Color fundus image — 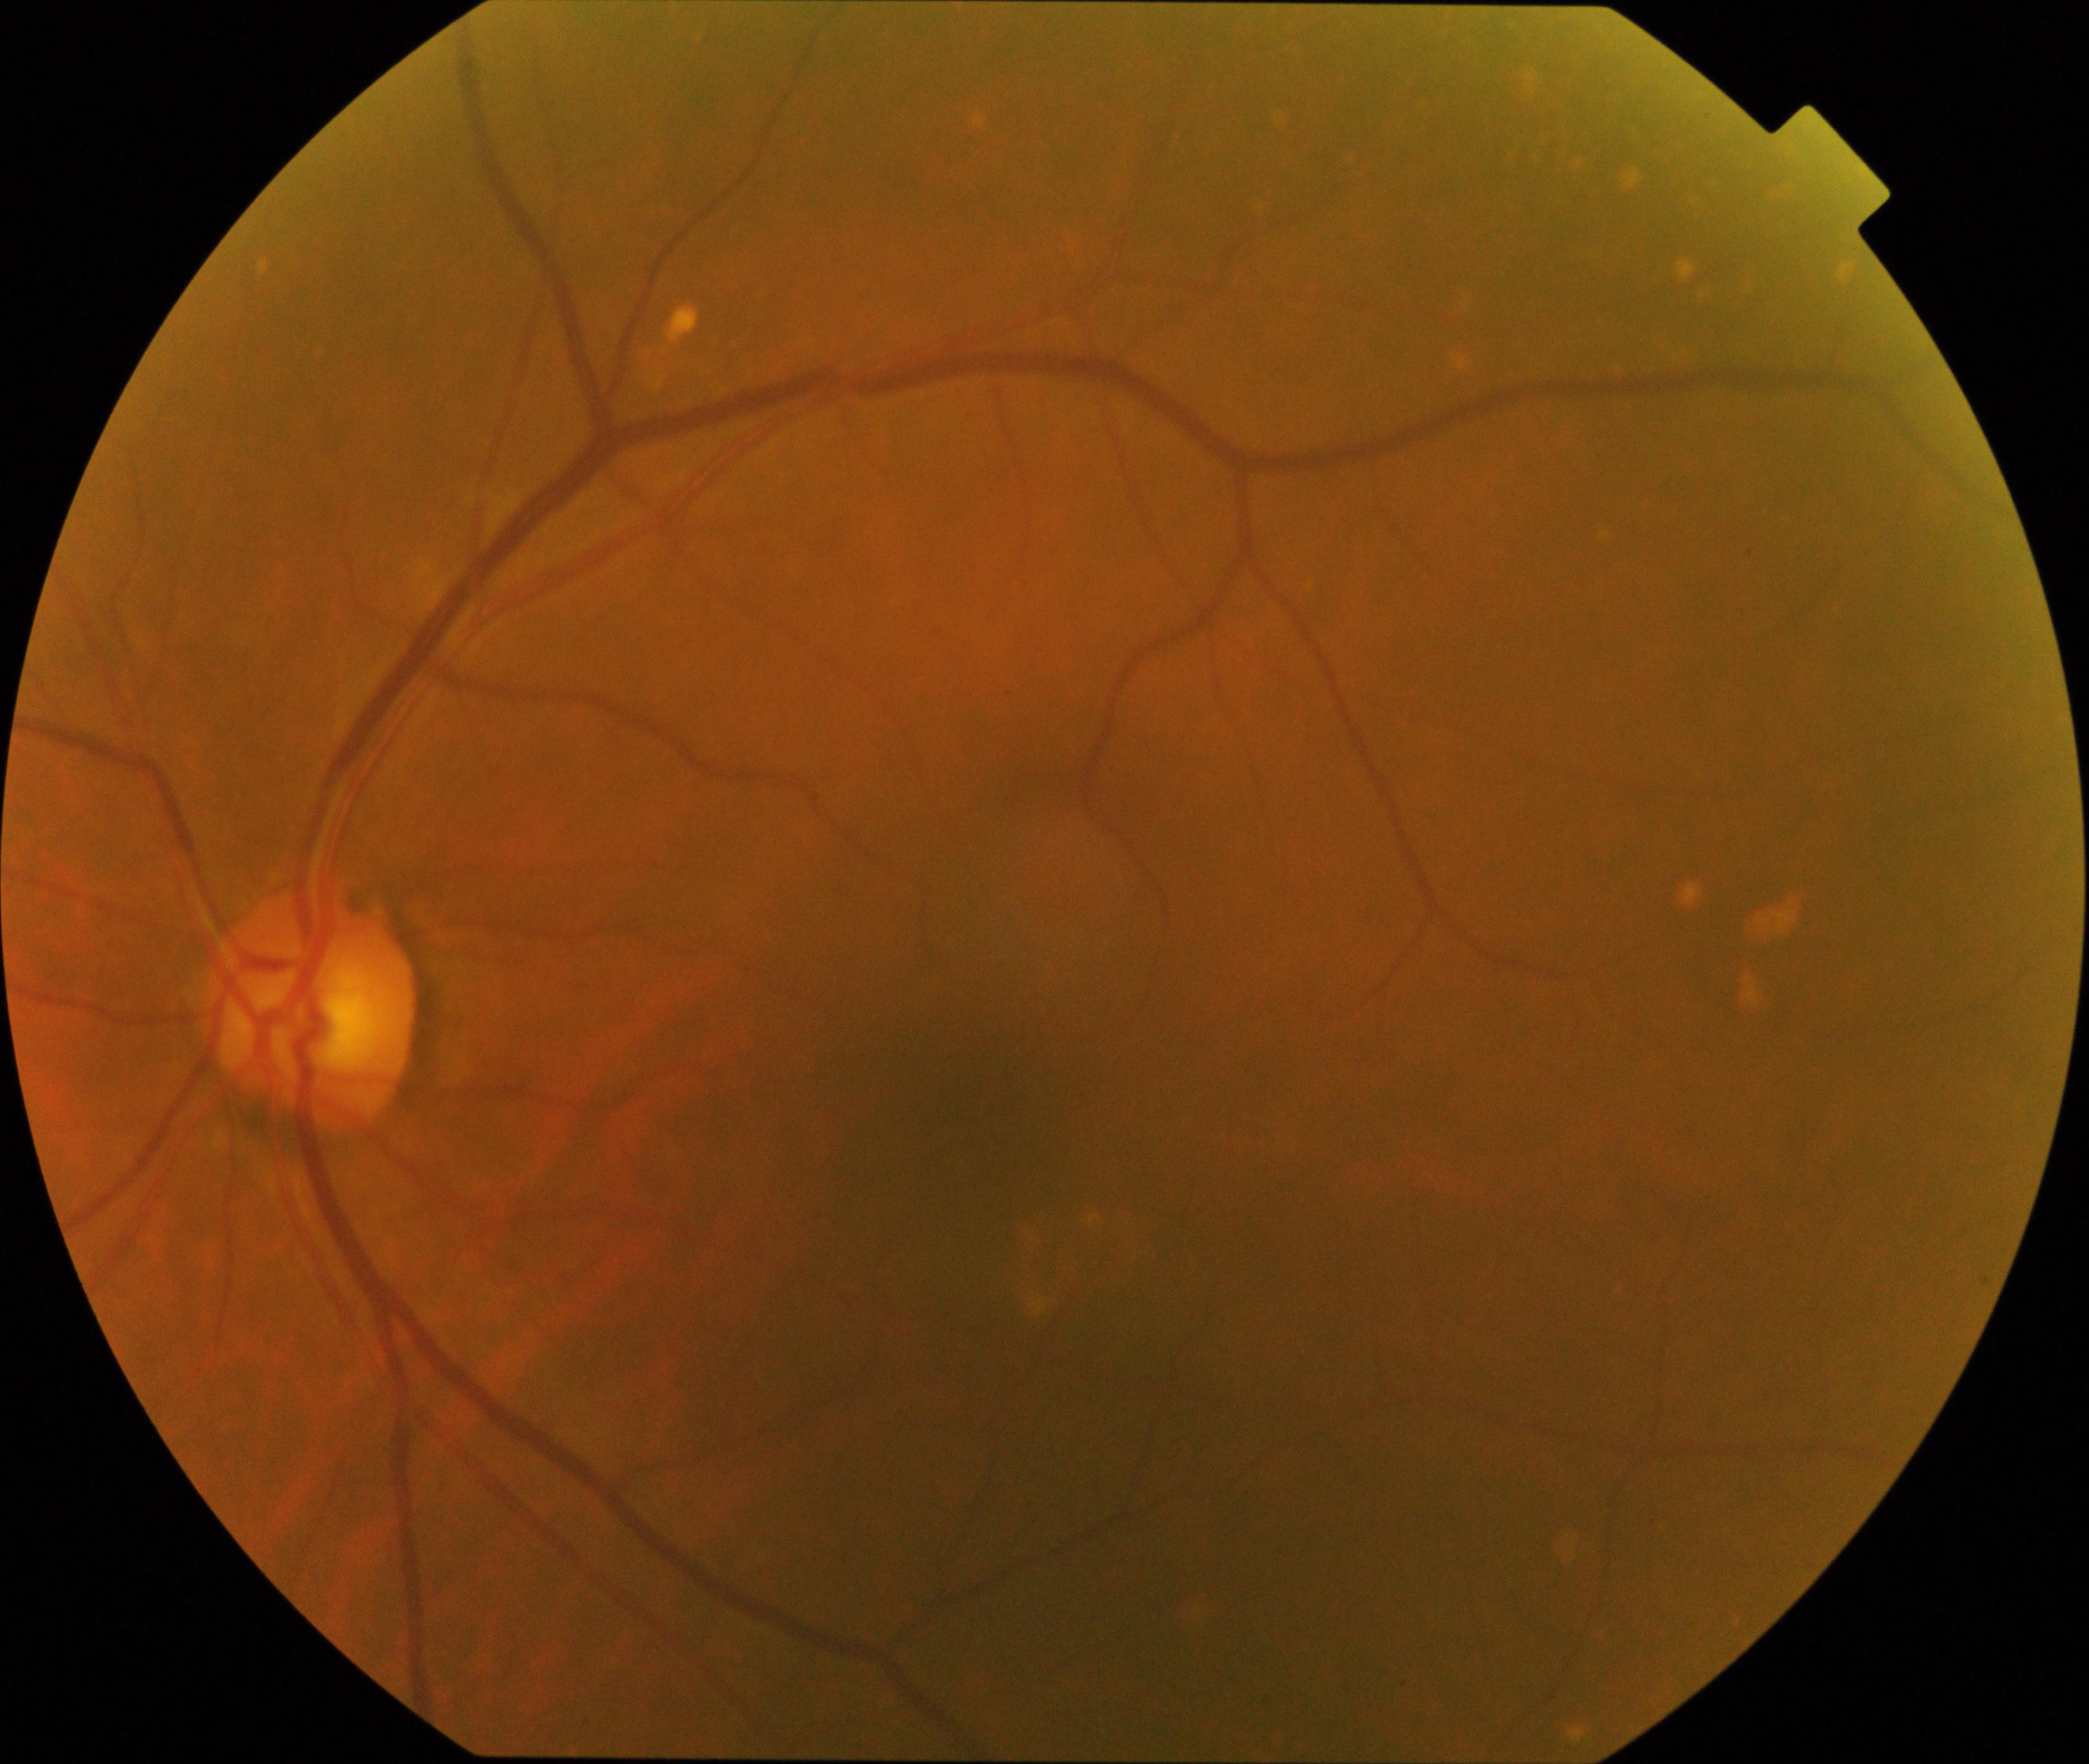
Appearance consistent with yellow-white spots or flecks.